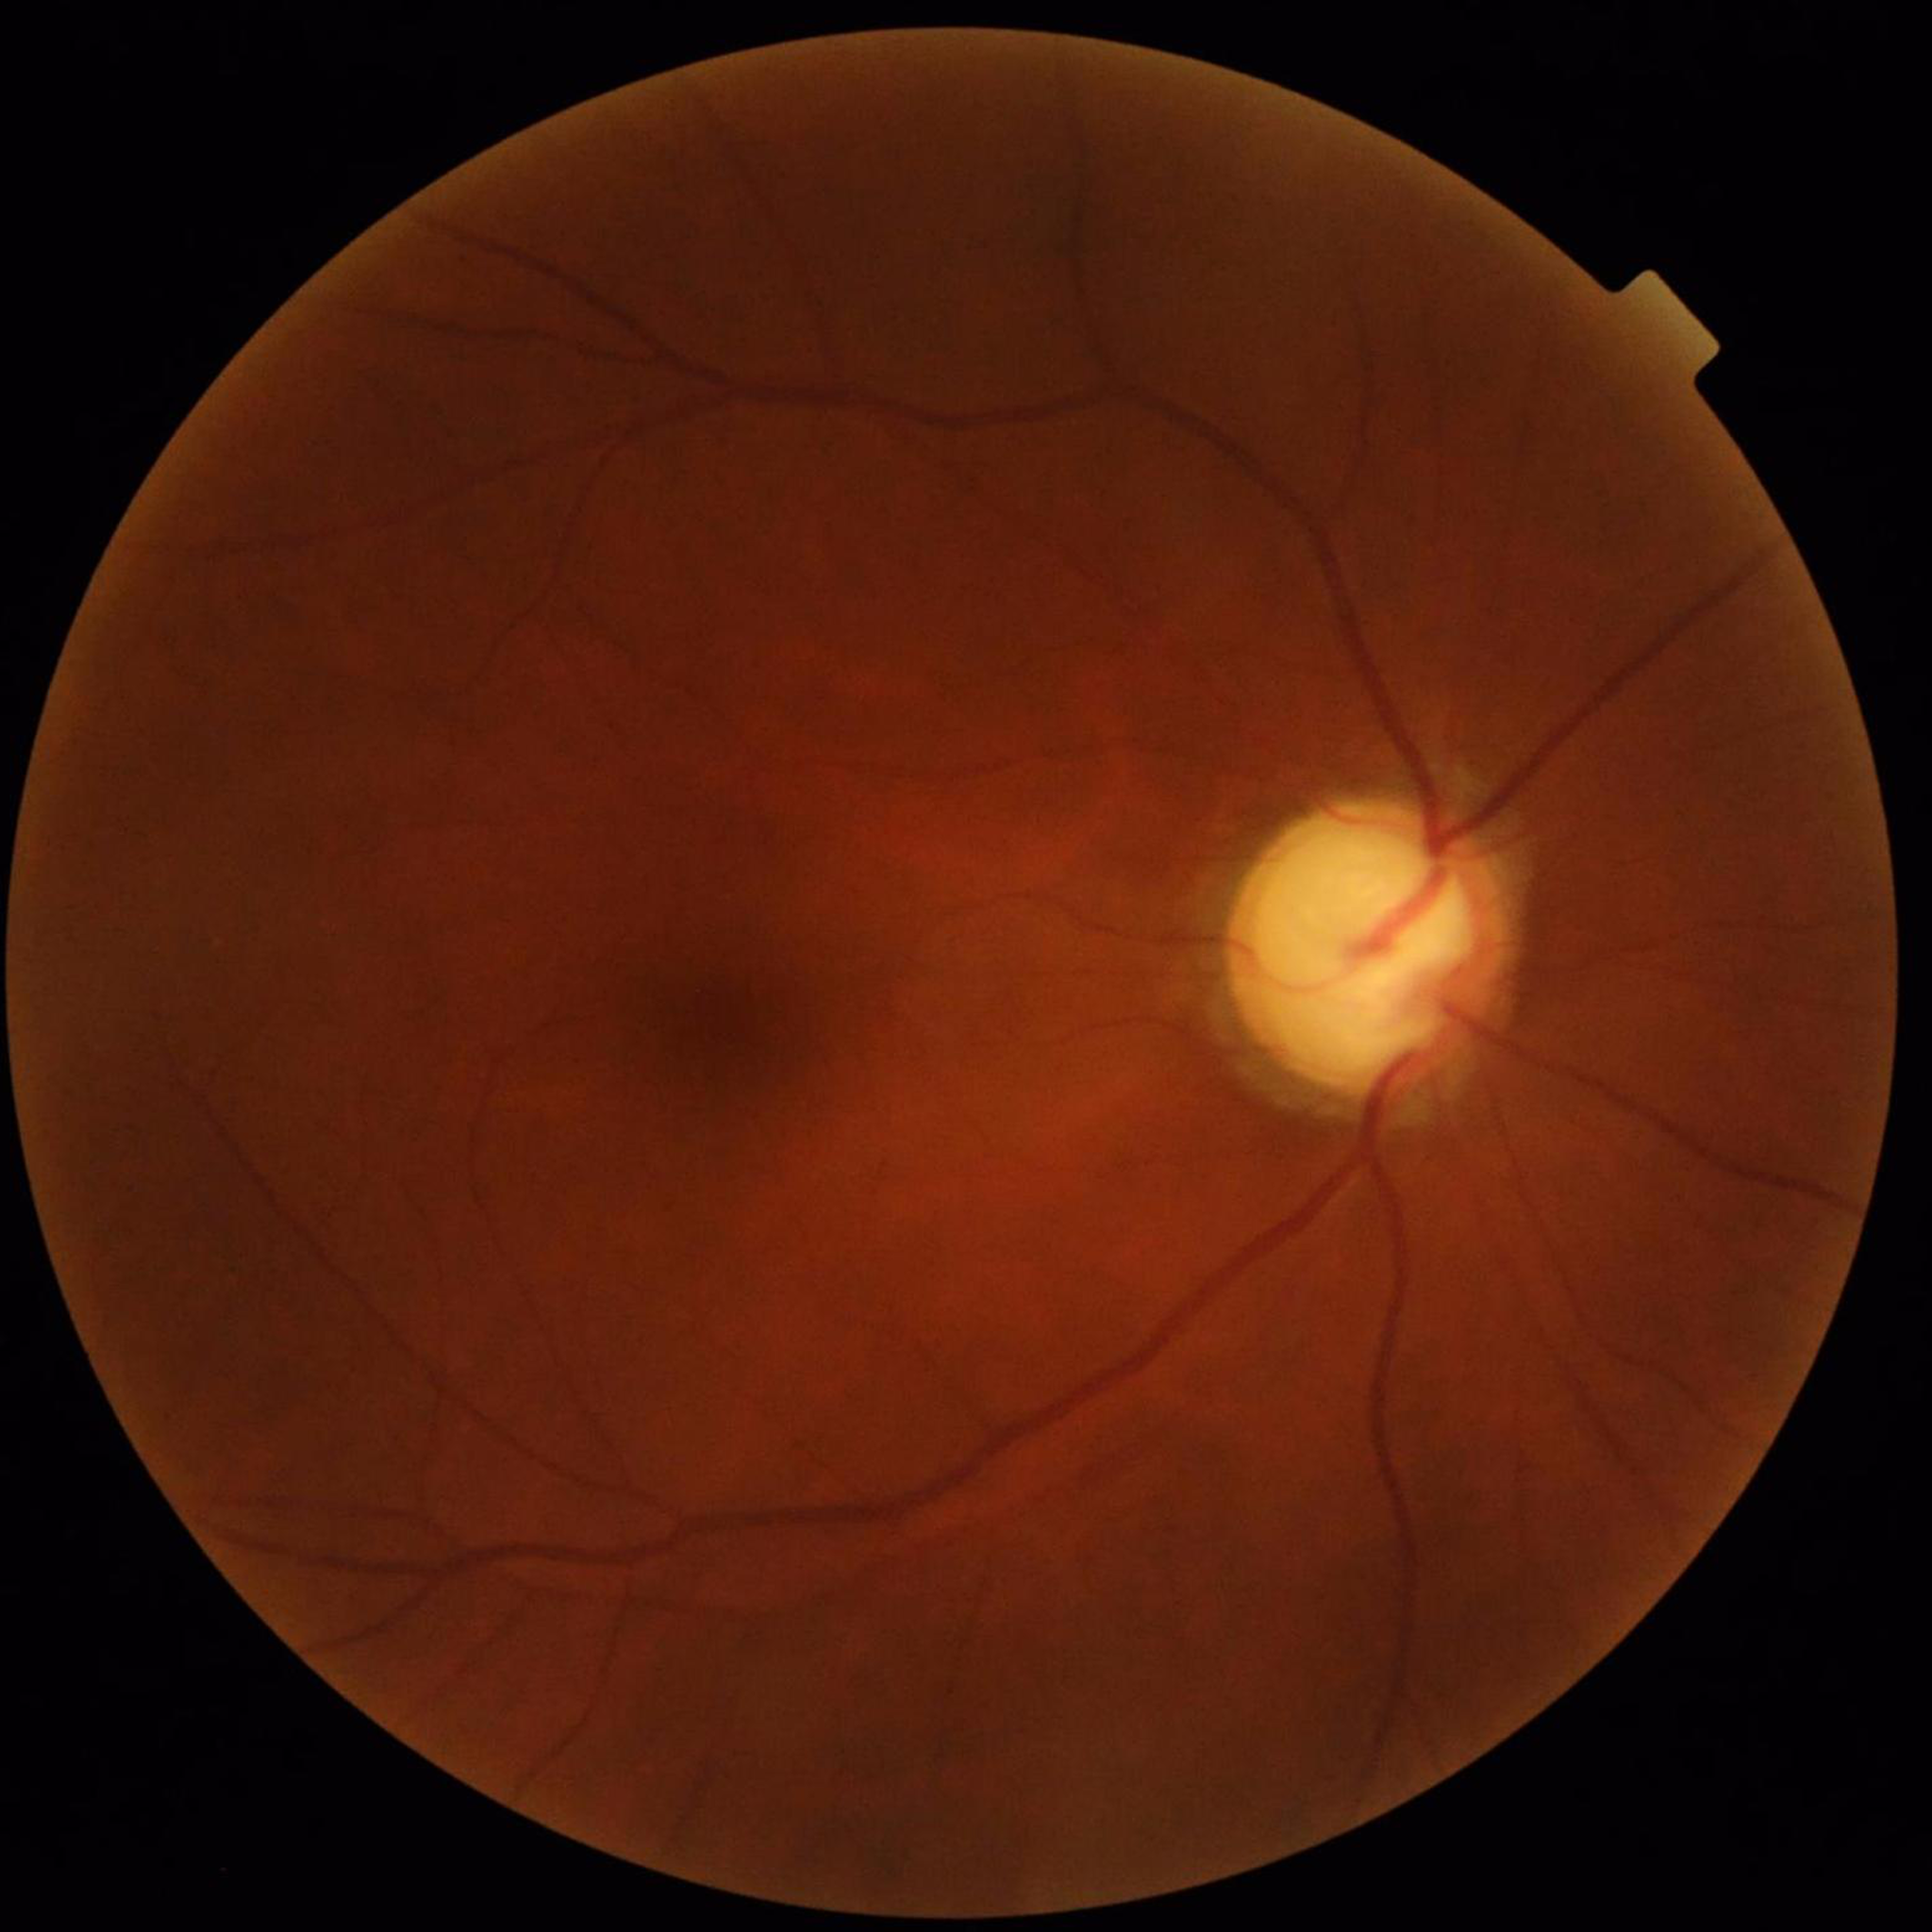 Eye affected by glaucoma.